45° field of view
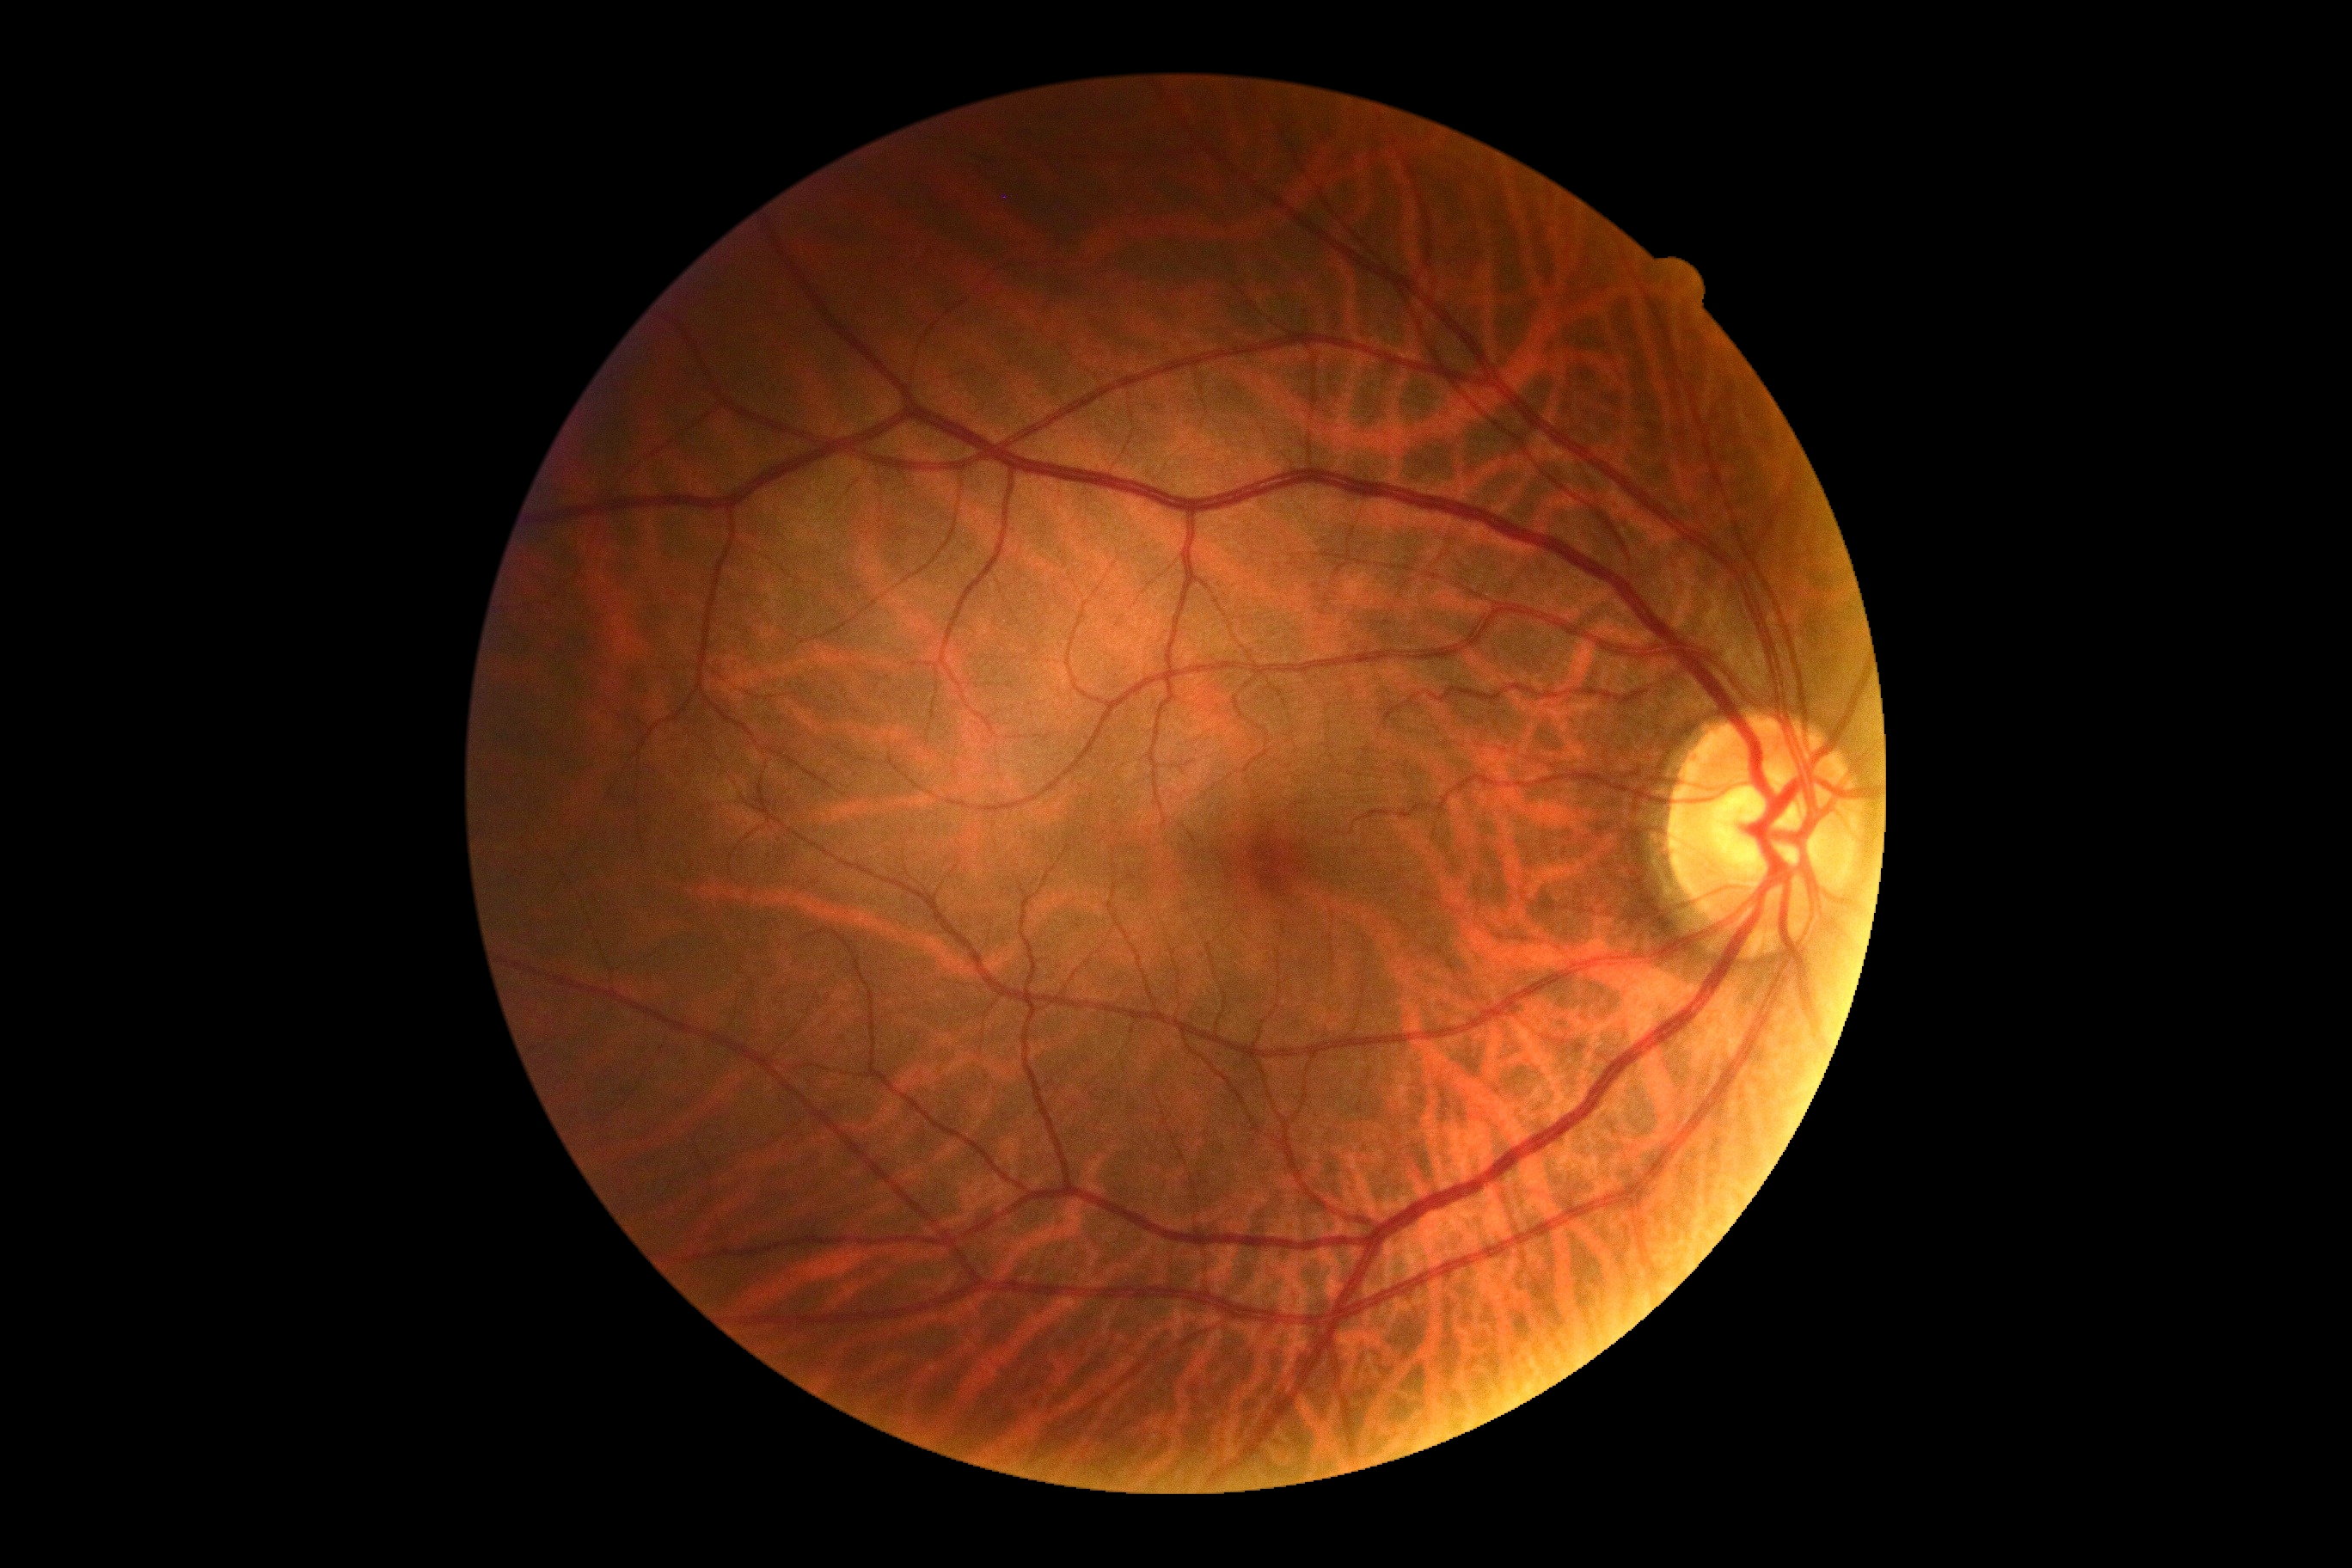
{
  "dr_grade": "no apparent diabetic retinopathy (grade 0)",
  "dr_impression": "no DR findings"
}